Davis DR grading
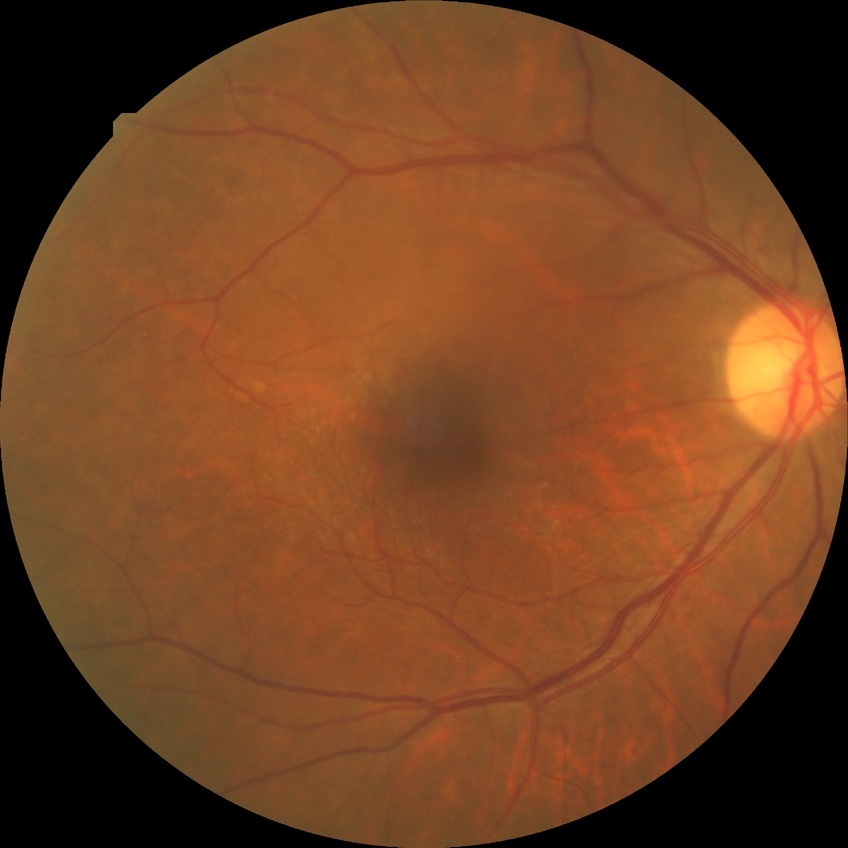
– Davis stage: NDR